Acquired on the Phoenix ICON. Wide-field fundus image from infant ROP screening. 1240 x 1240 pixels: 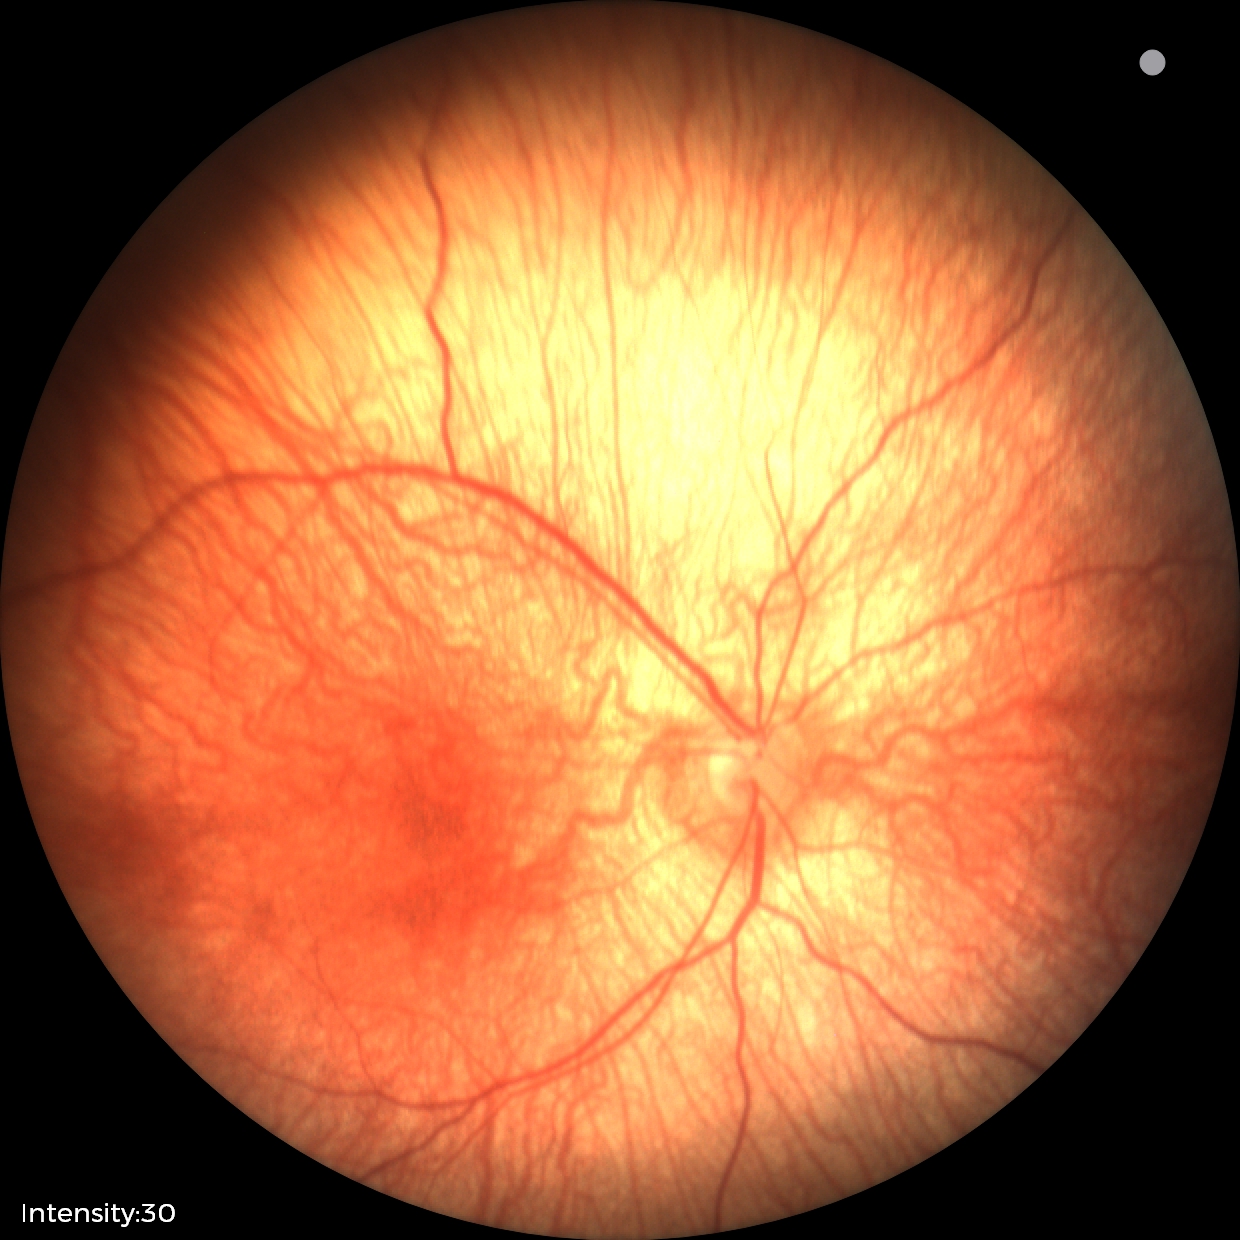 Screening diagnosis: normal.